Image size 640x480 · wide-field fundus image from infant ROP screening
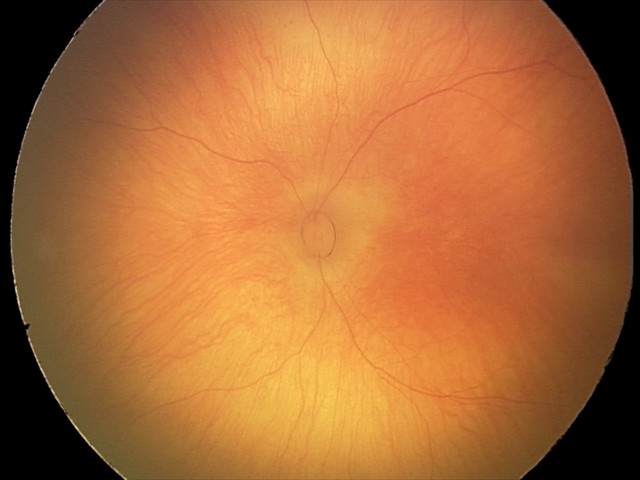
Screening examination diagnosed as physiological.